Non-mydriatic fundus camera; optic disc region crop; 240x240px:
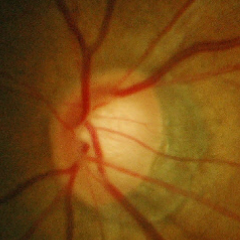 Glaucoma is present. Assessment = early glaucomatous changes.